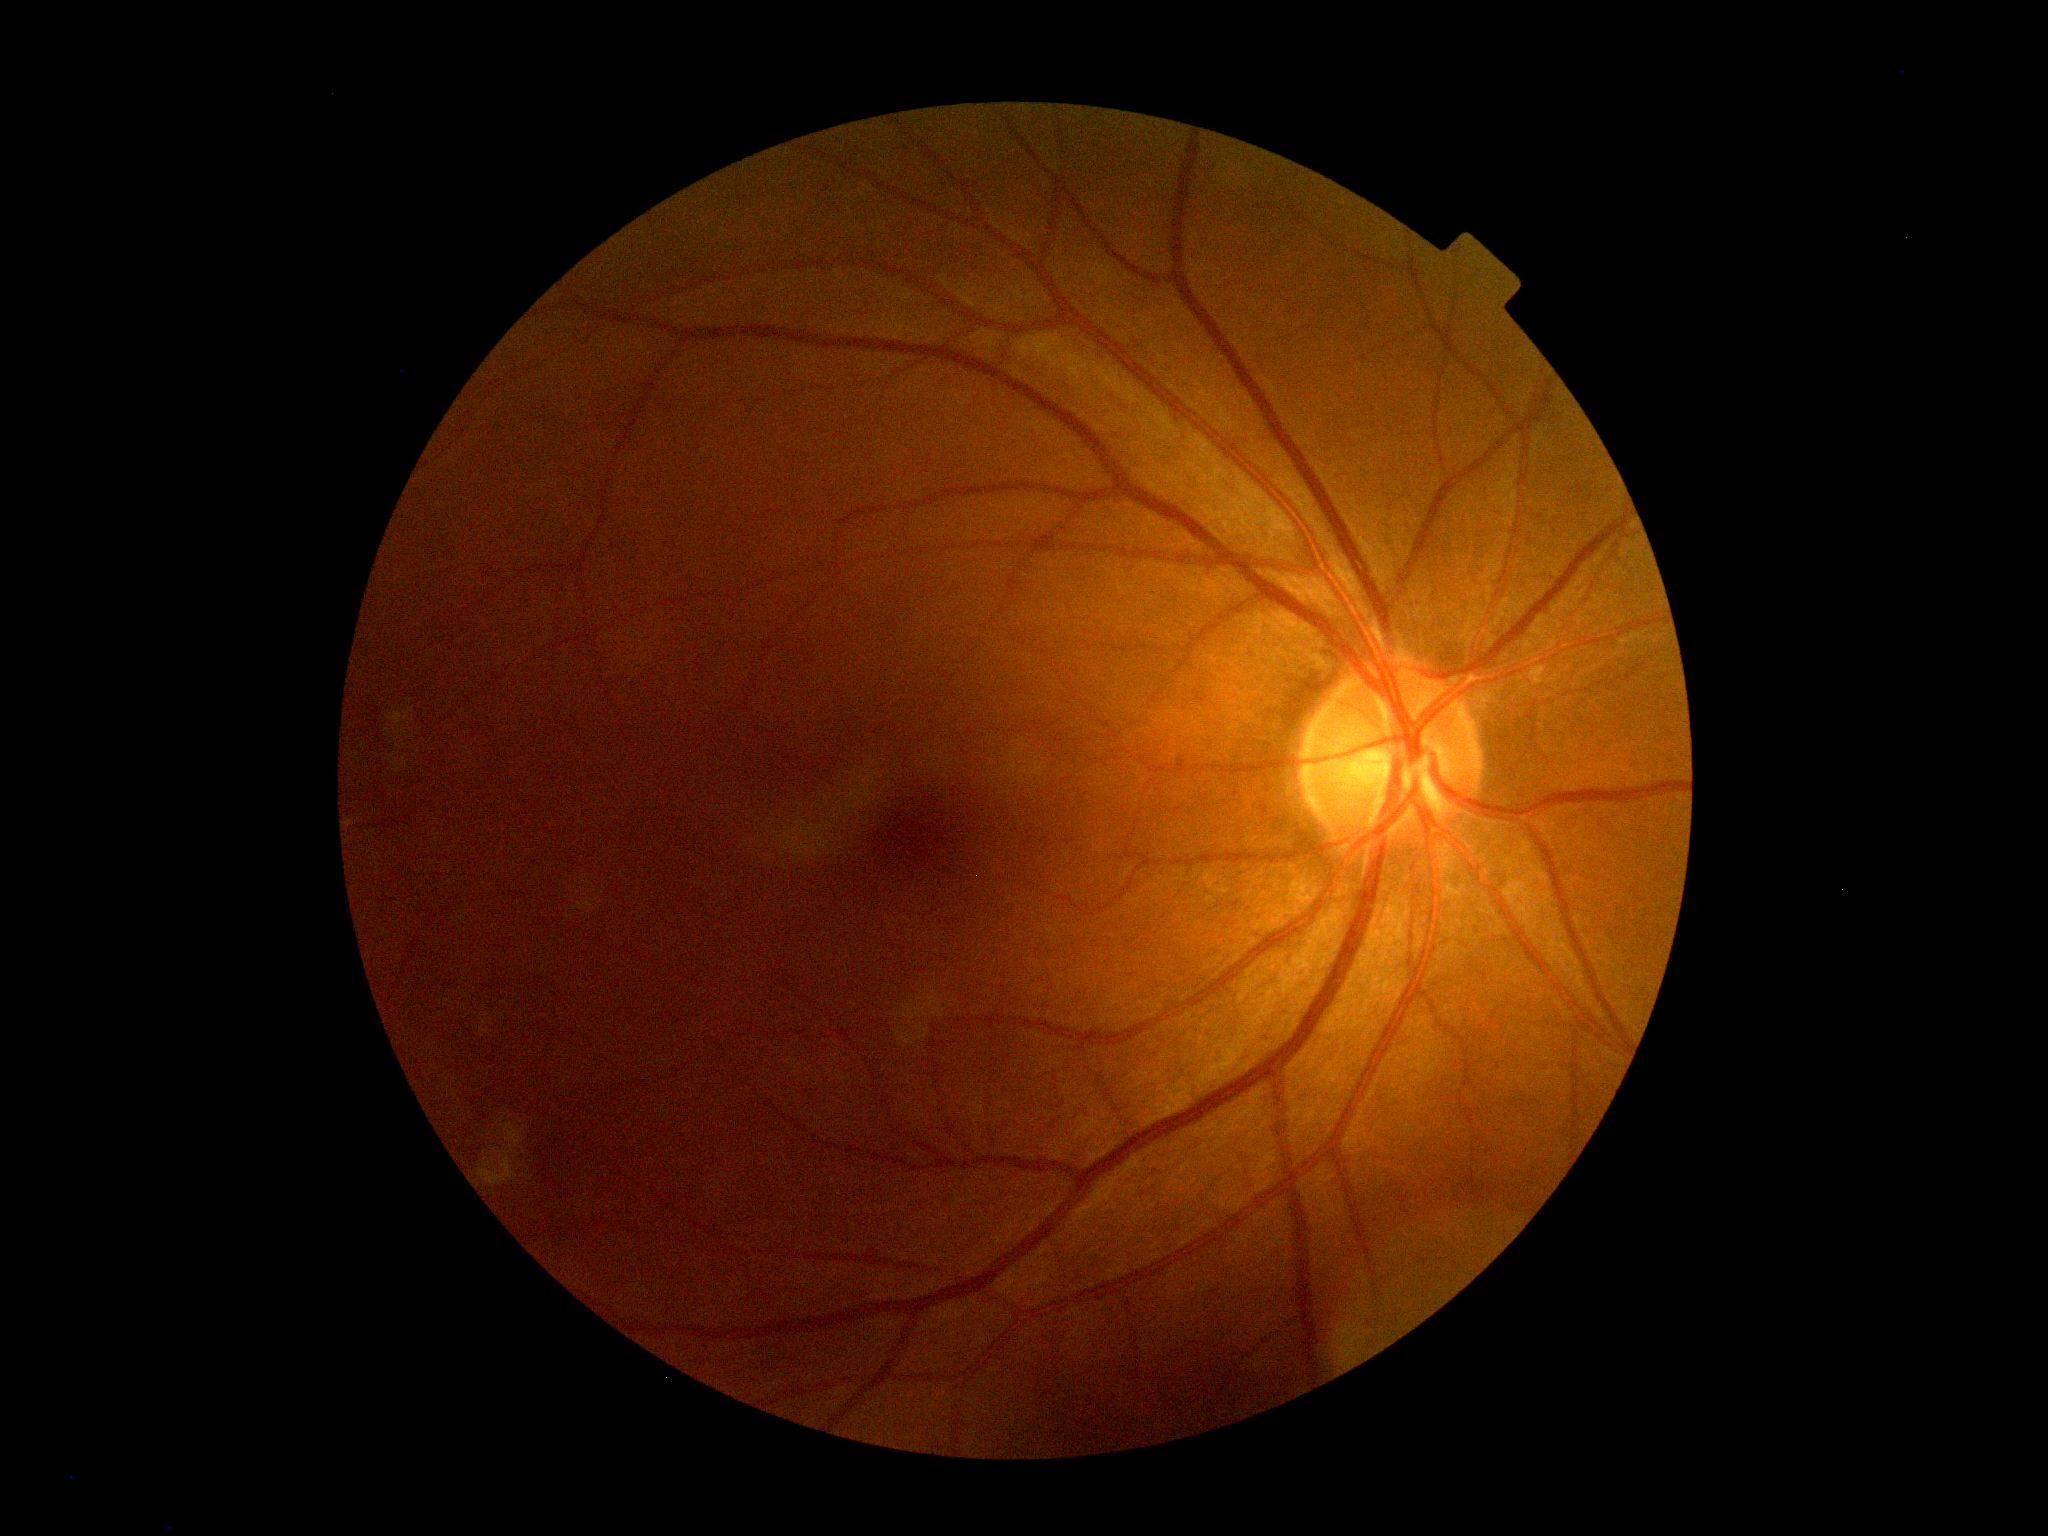 dr_grade: 0/4
dr_impression: negative for DR